Wide-field fundus photograph of an infant
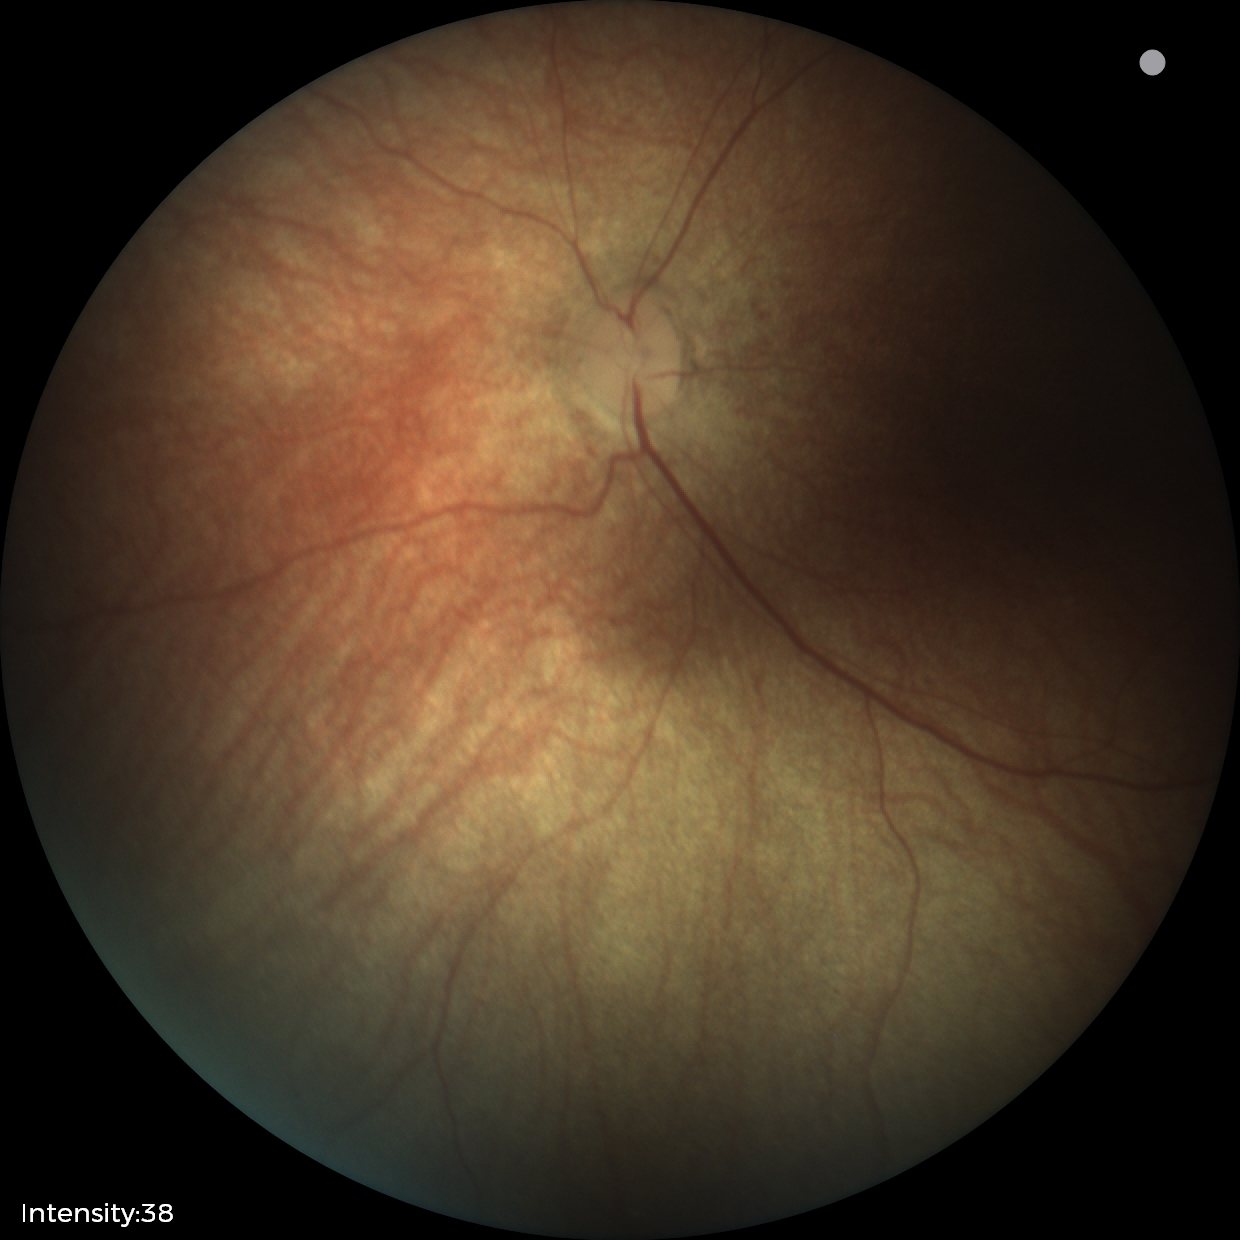 No retinal pathology identified on screening.